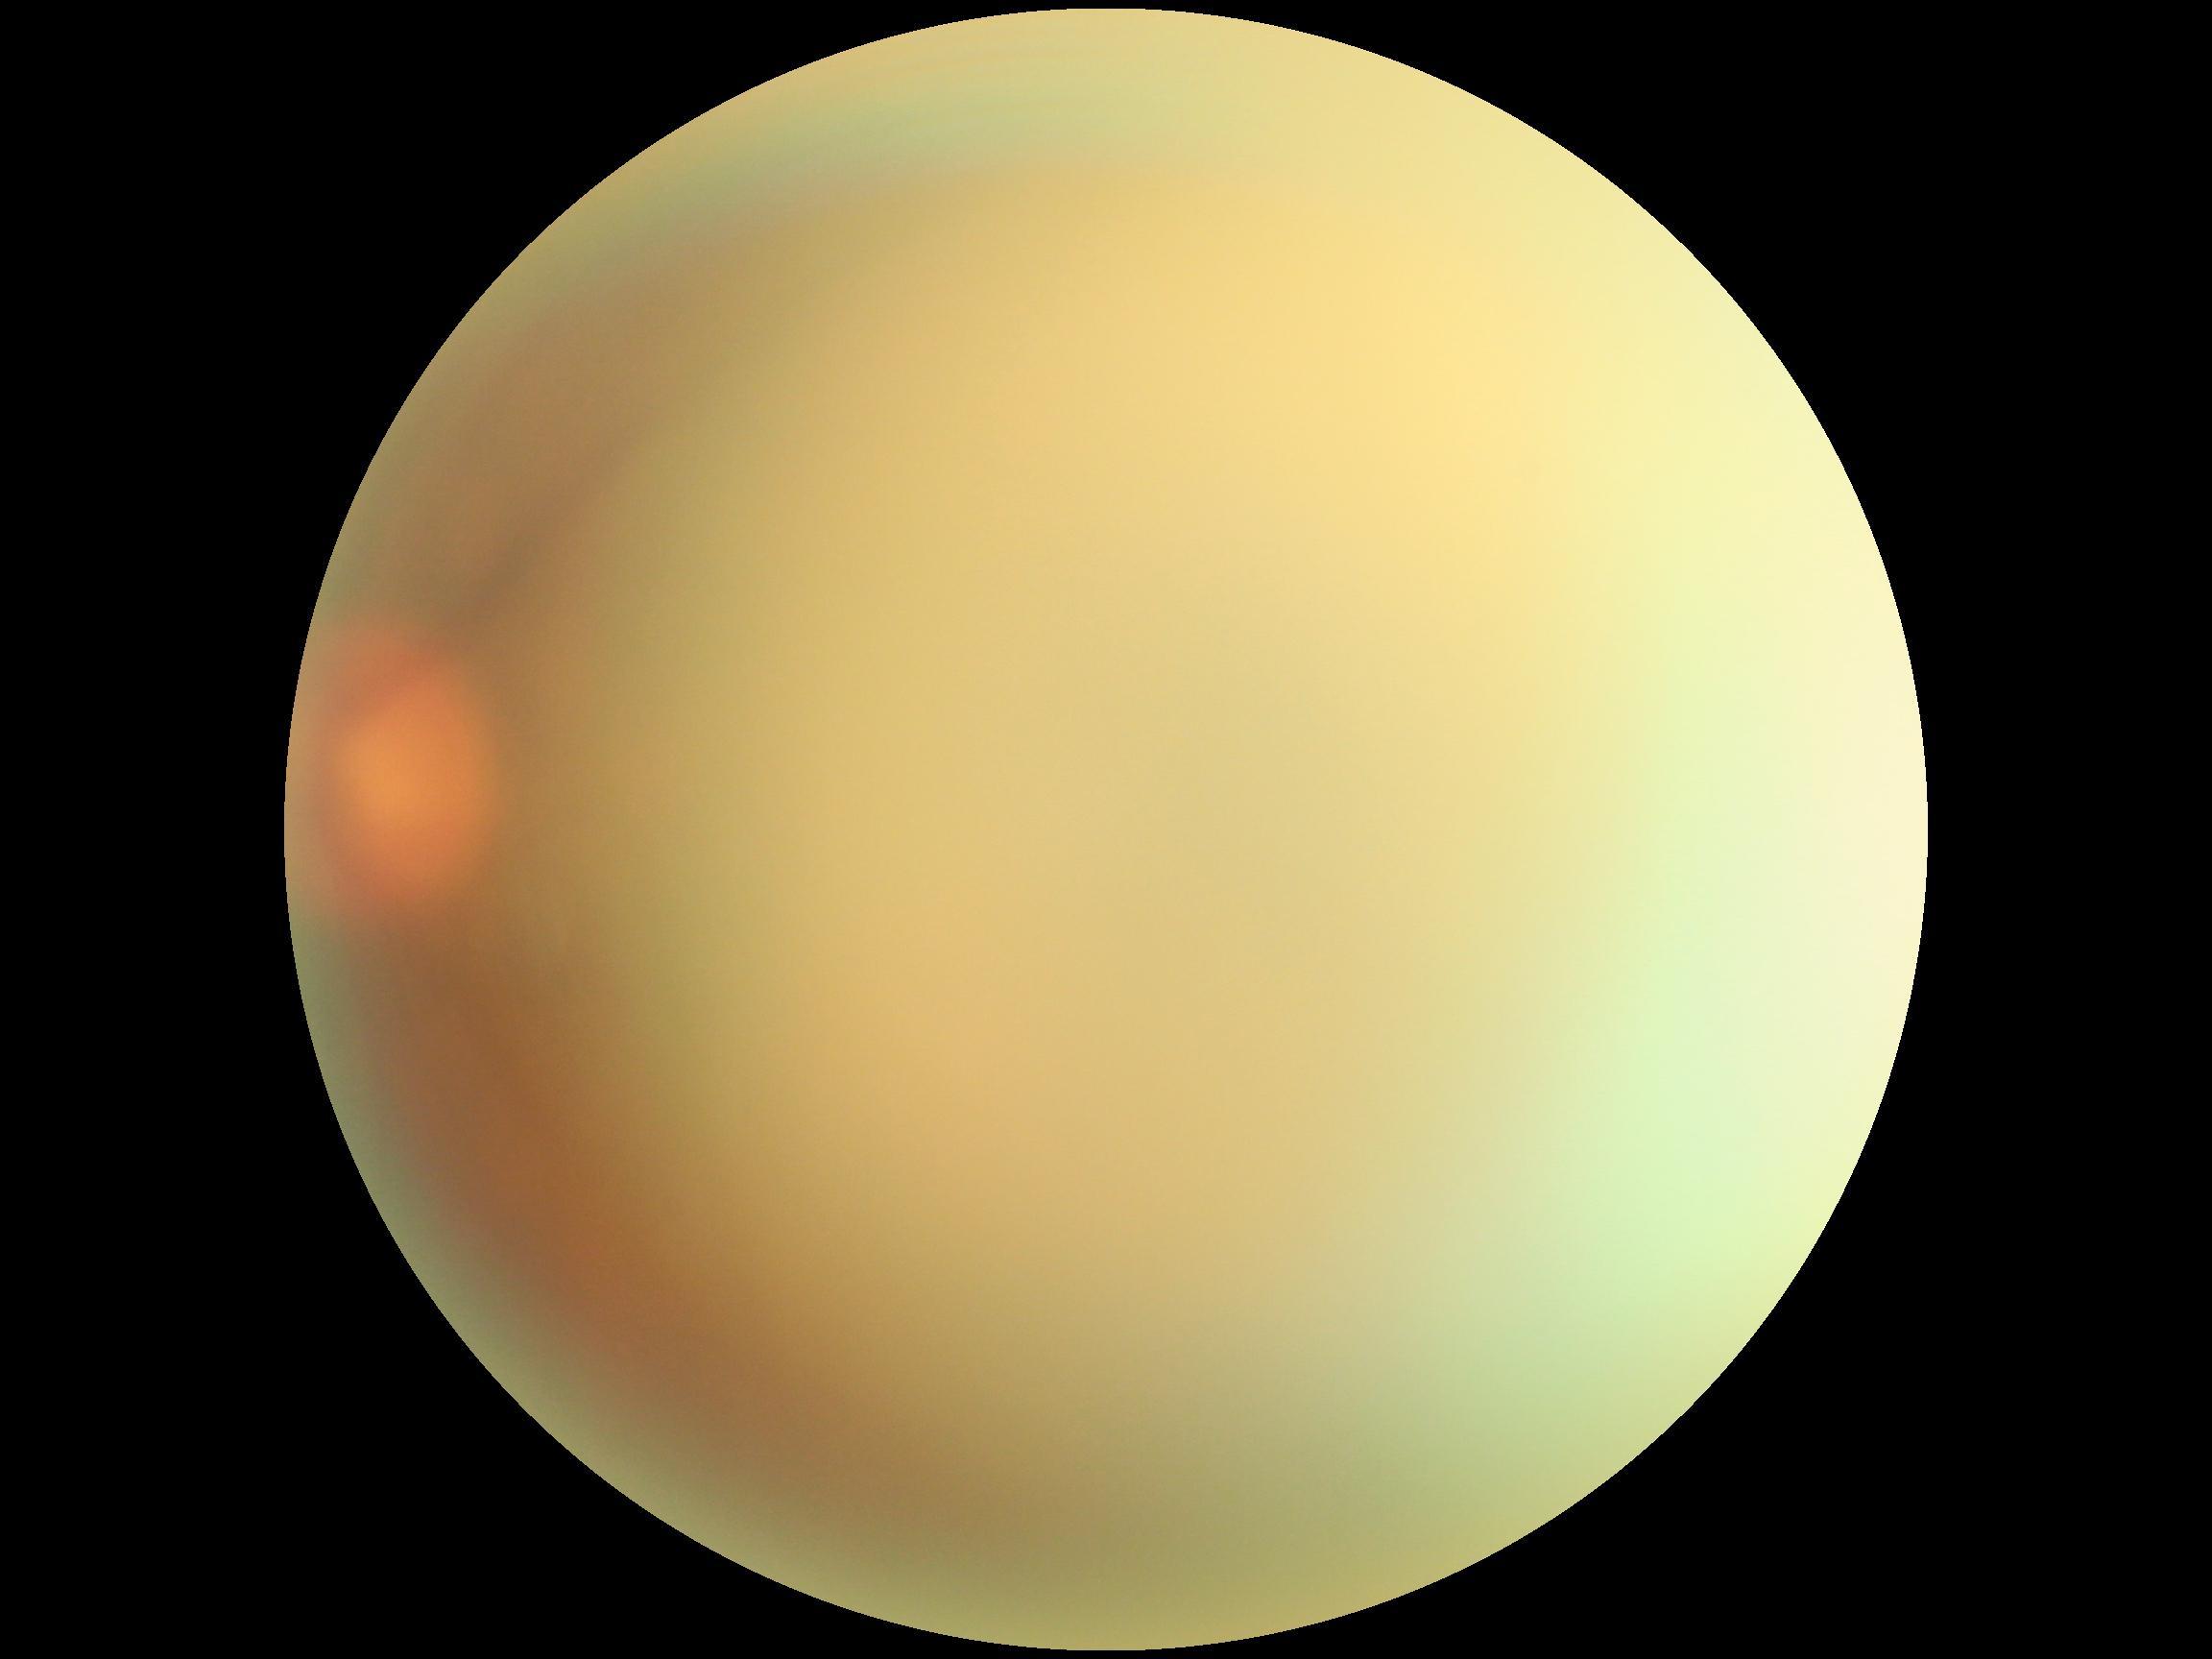
DR severity is ungradable due to poor image quality. The image cannot be graded for diabetic retinopathy.